Pediatric retinal photograph (wide-field):
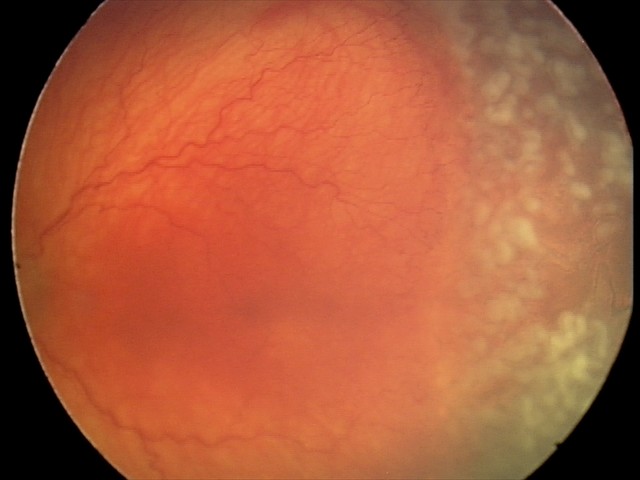 From an examination with diagnosis of aggressive retinopathy of prematurity (A-ROP). Plus disease present.